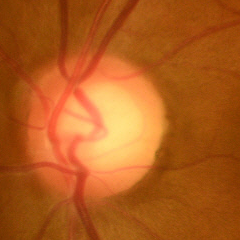
Fundus appearance consistent with no glaucomatous optic neuropathy.